45-degree field of view · 2352 x 1568 pixels.
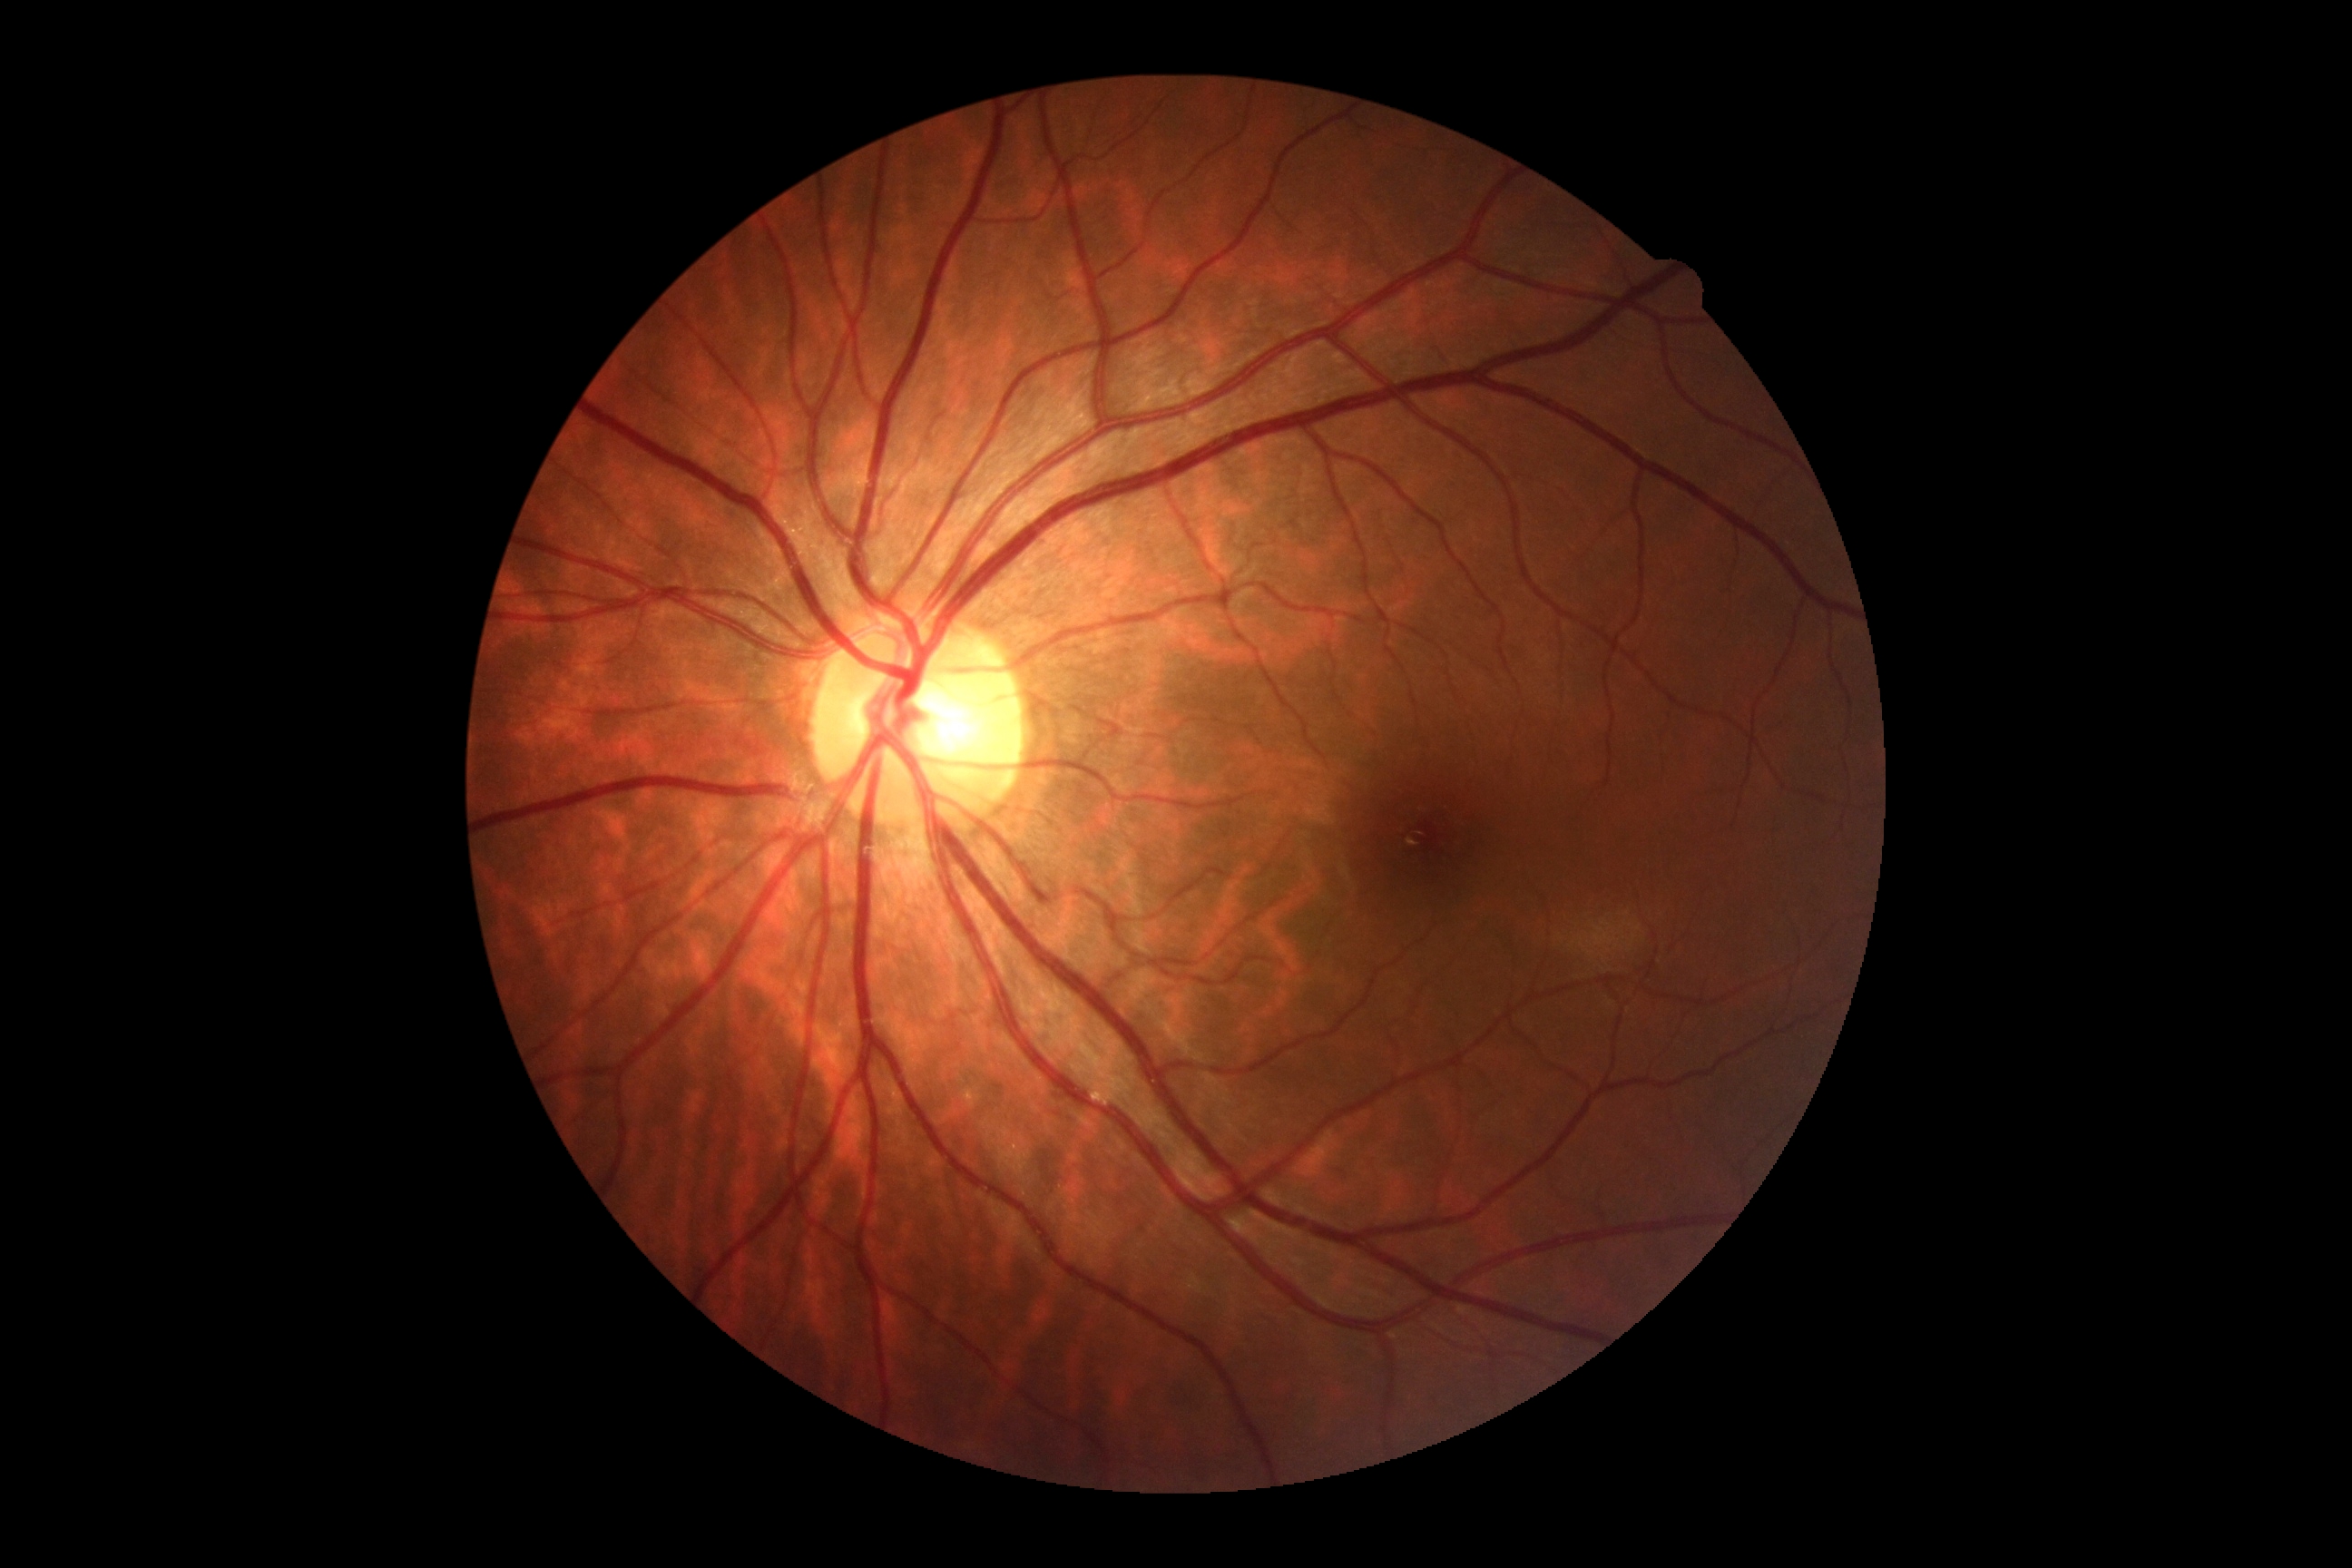 Annotations:
– diabetic retinopathy (DR): no apparent retinopathy (grade 0)